Without pupil dilation, DR severity per modified Davis staging
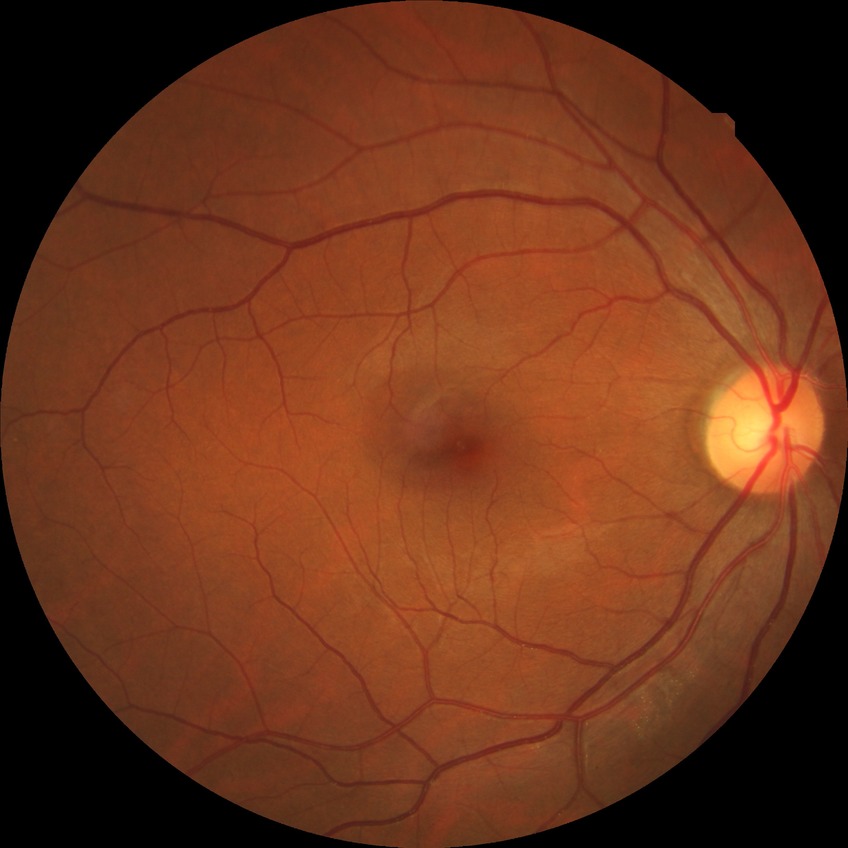 Diabetic retinopathy stage: no diabetic retinopathy.